Color fundus image.
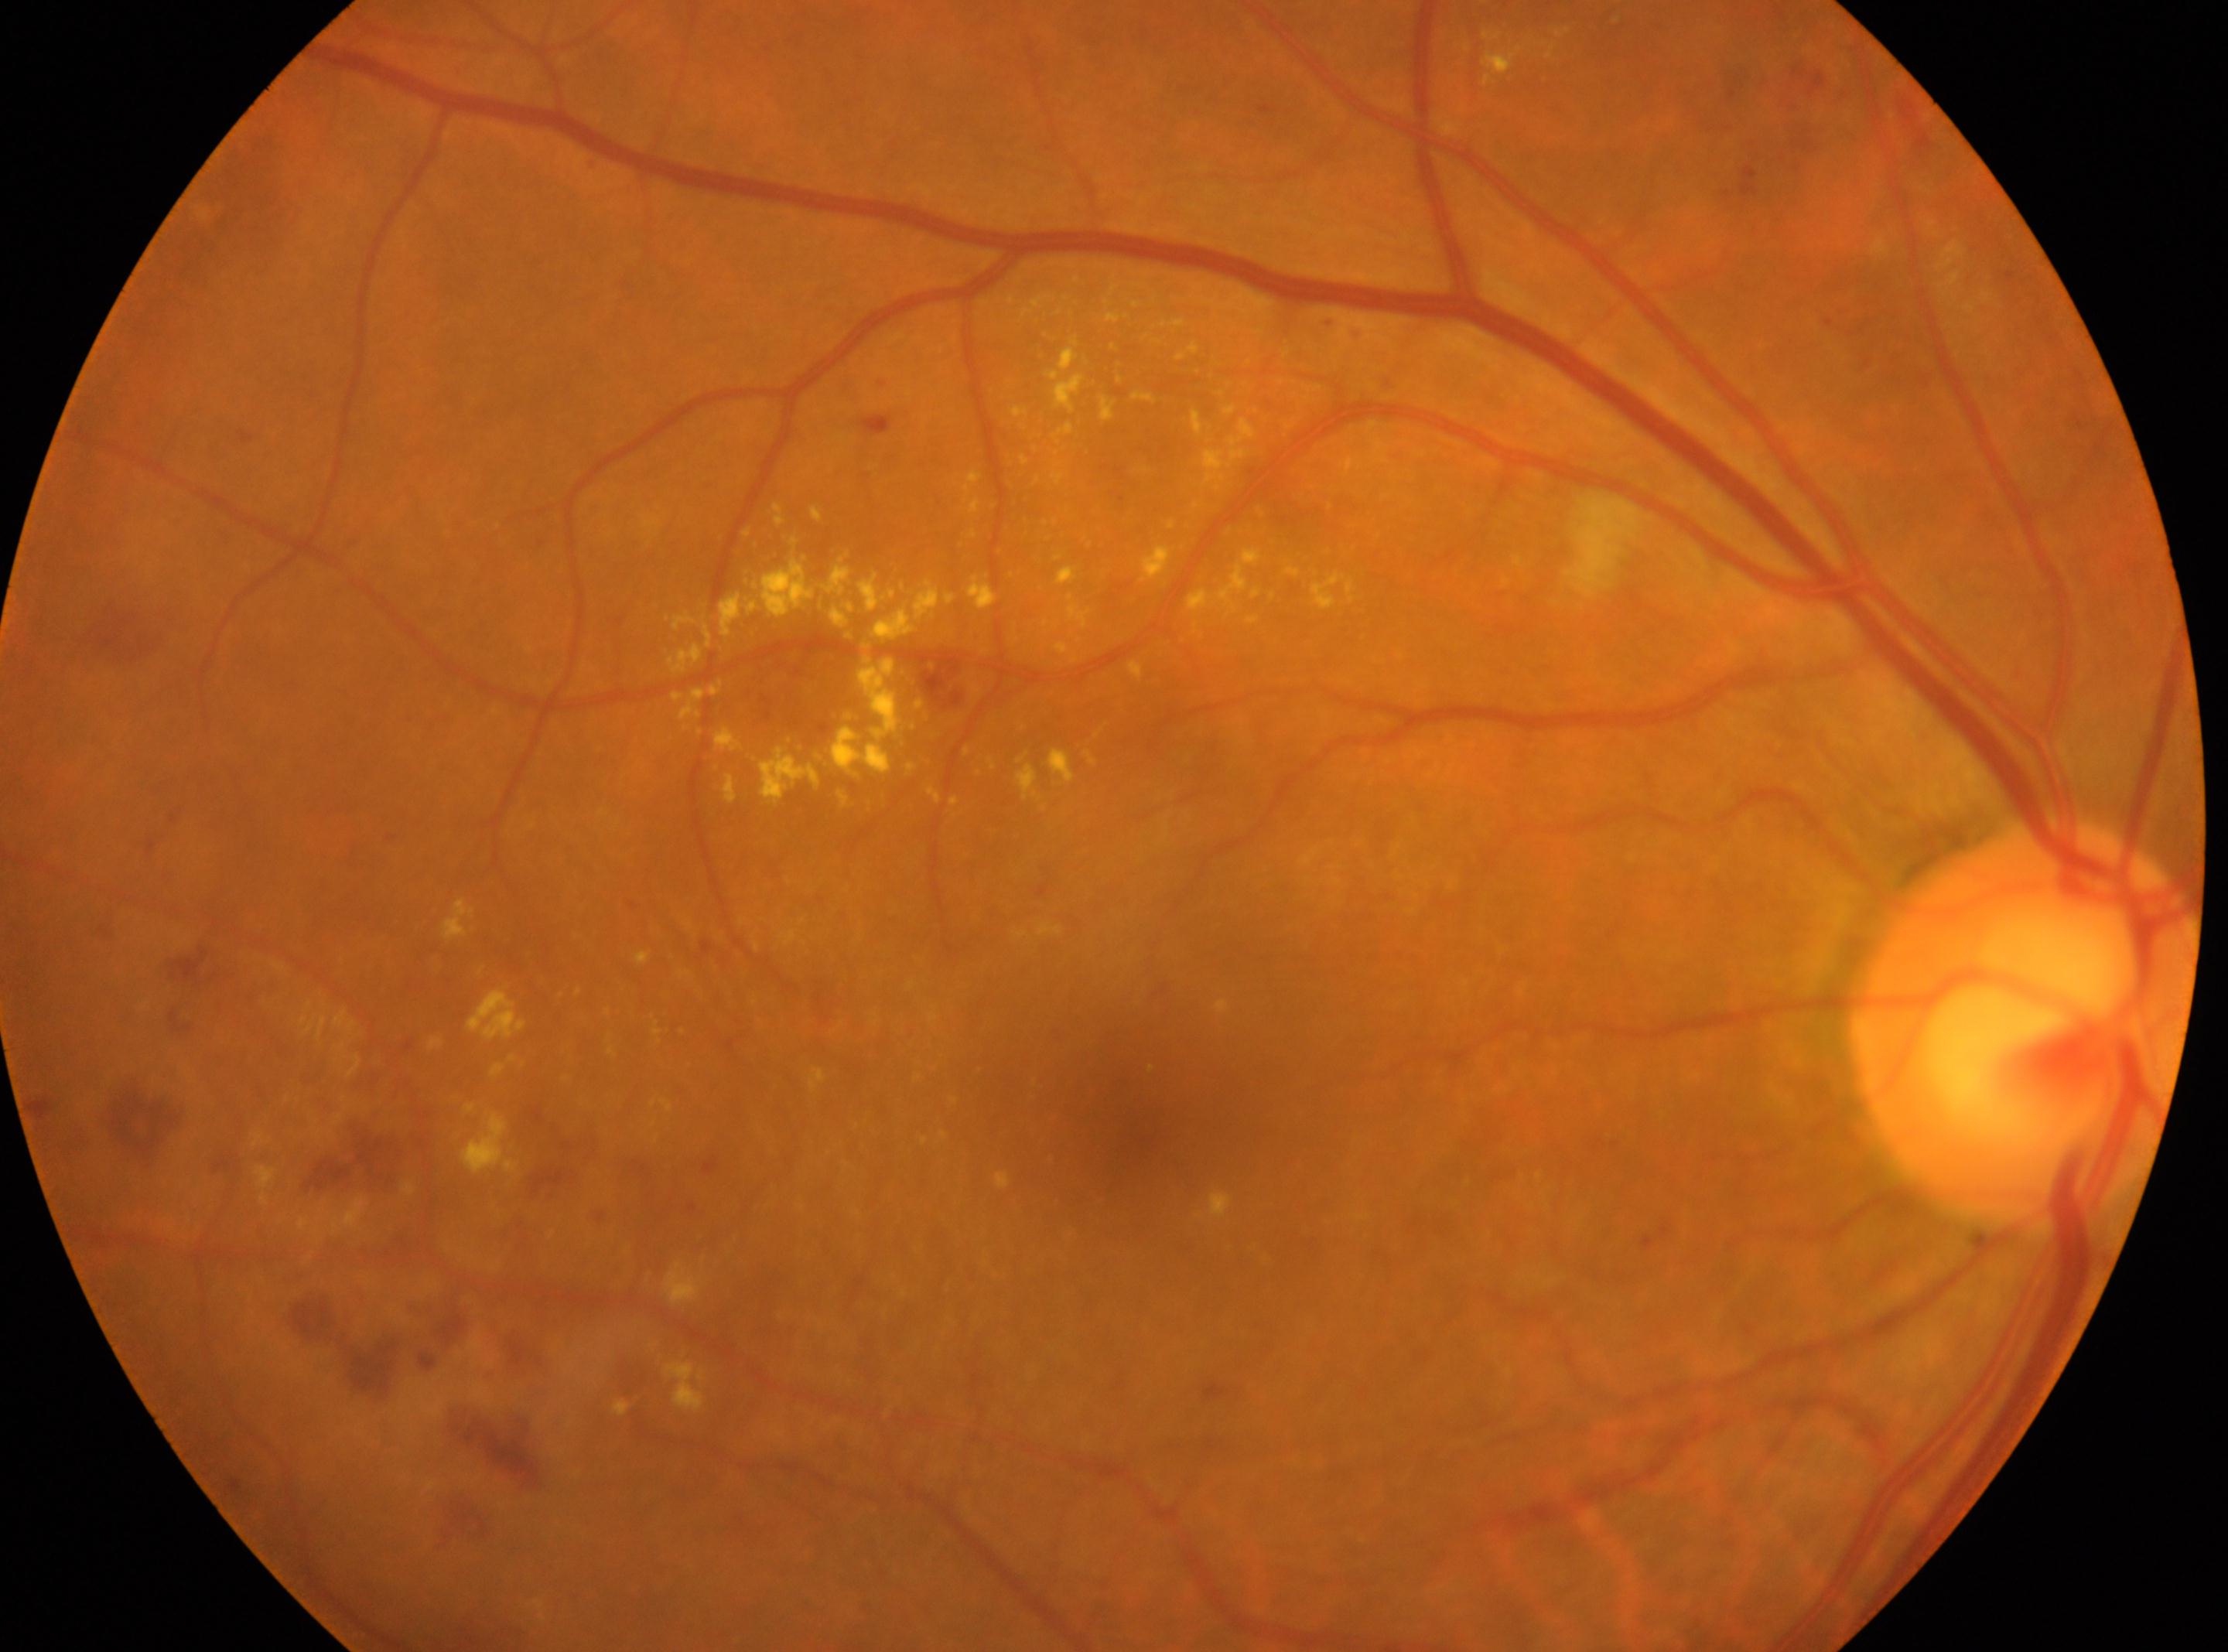

Optic disc located at 2022px, 1026px. Eye: oculus dexter. DR grade: 2. Fovea located at 1136px, 1129px.